45° field of view, 848 by 848 pixels.
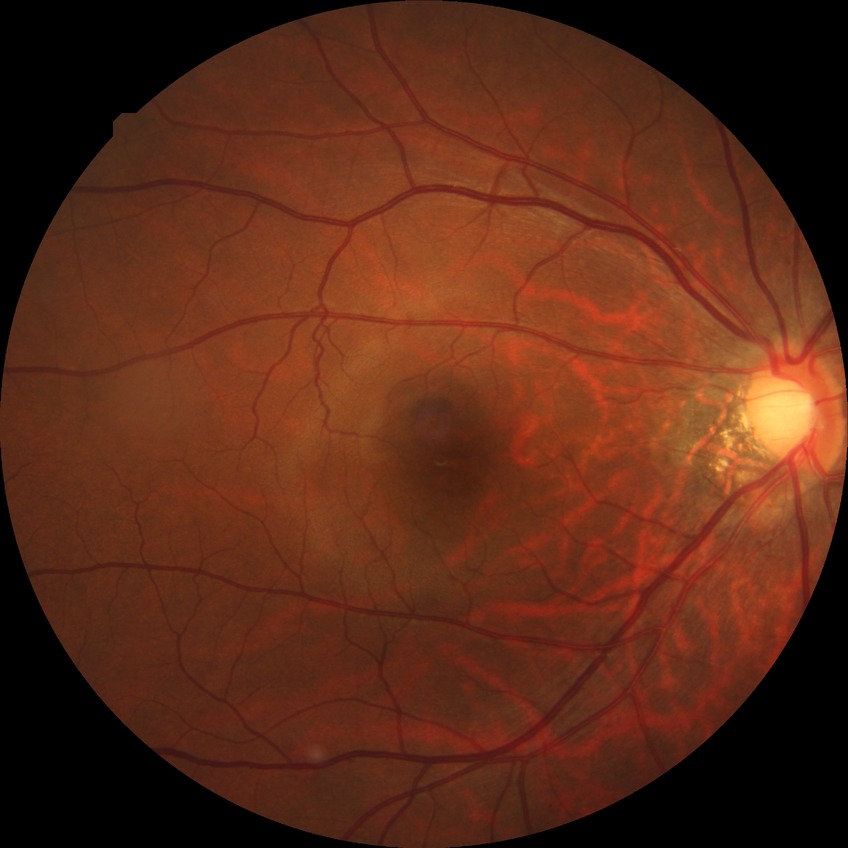
davis_grade: no diabetic retinopathy (NDR)